Color fundus photograph · FOV: 45 degrees:
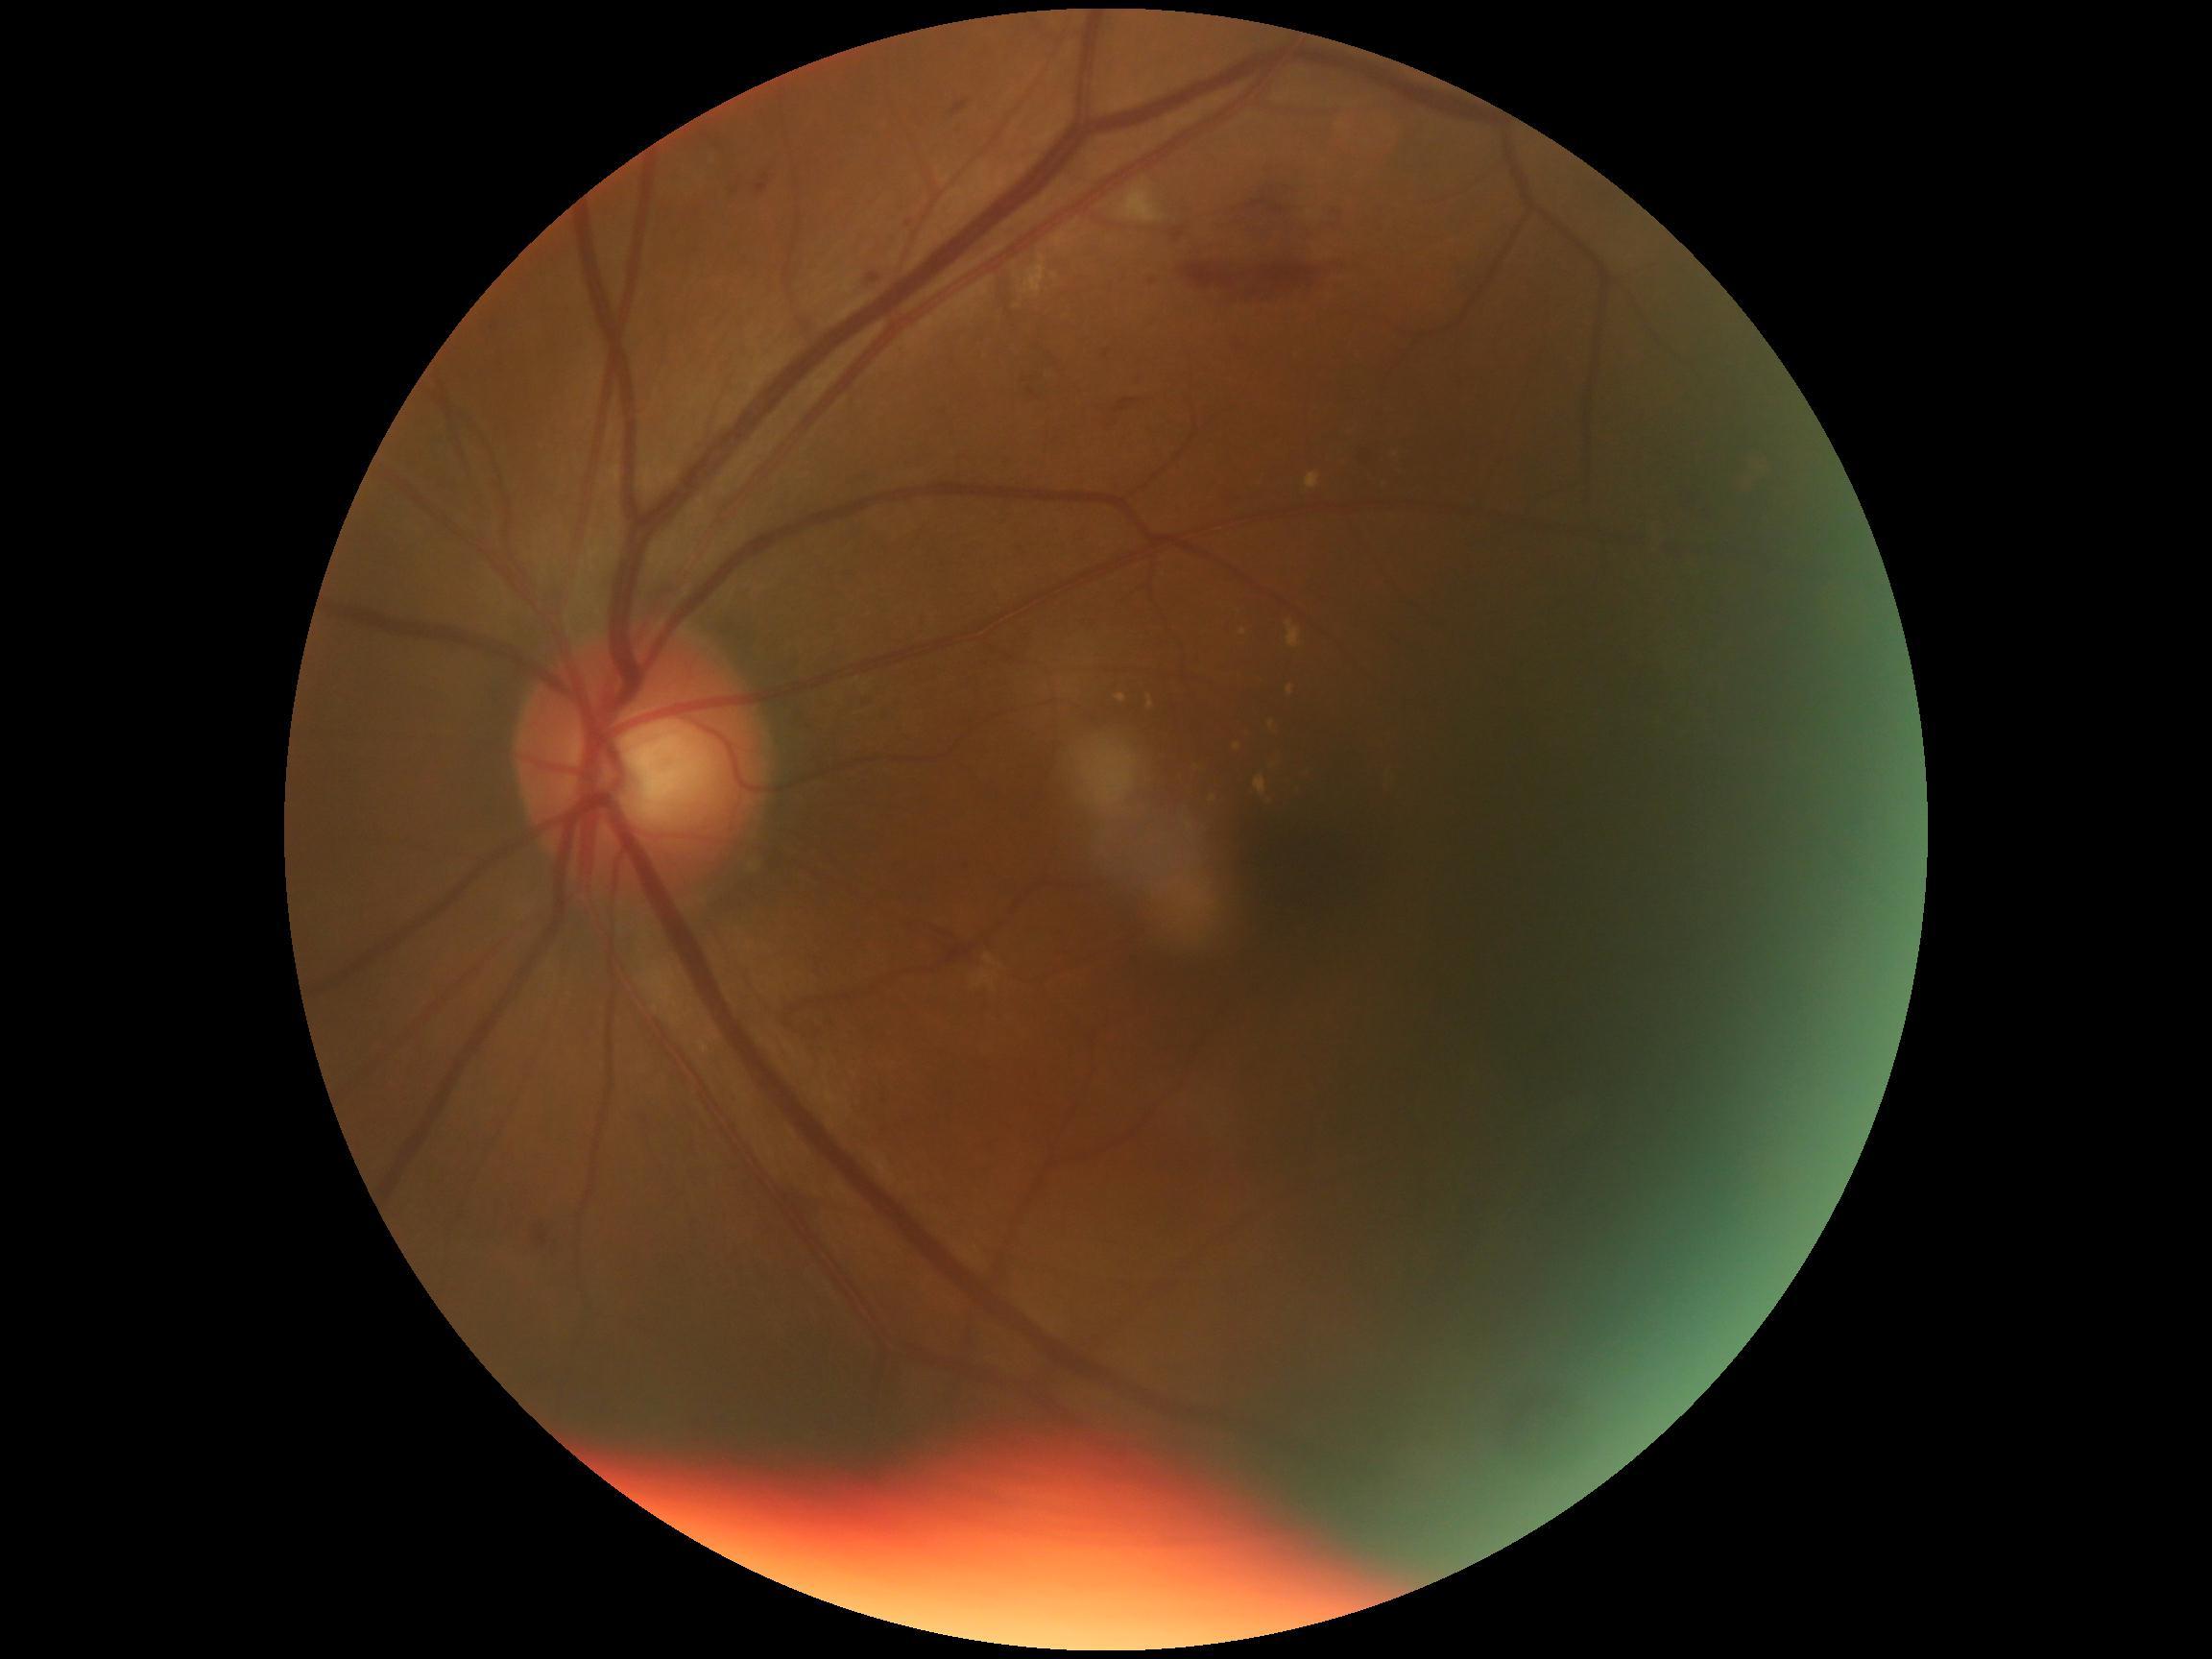
{
  "dr_grade": "2 (moderate NPDR)"
}